1440 x 1080 pixels. Pediatric wide-field fundus photograph:
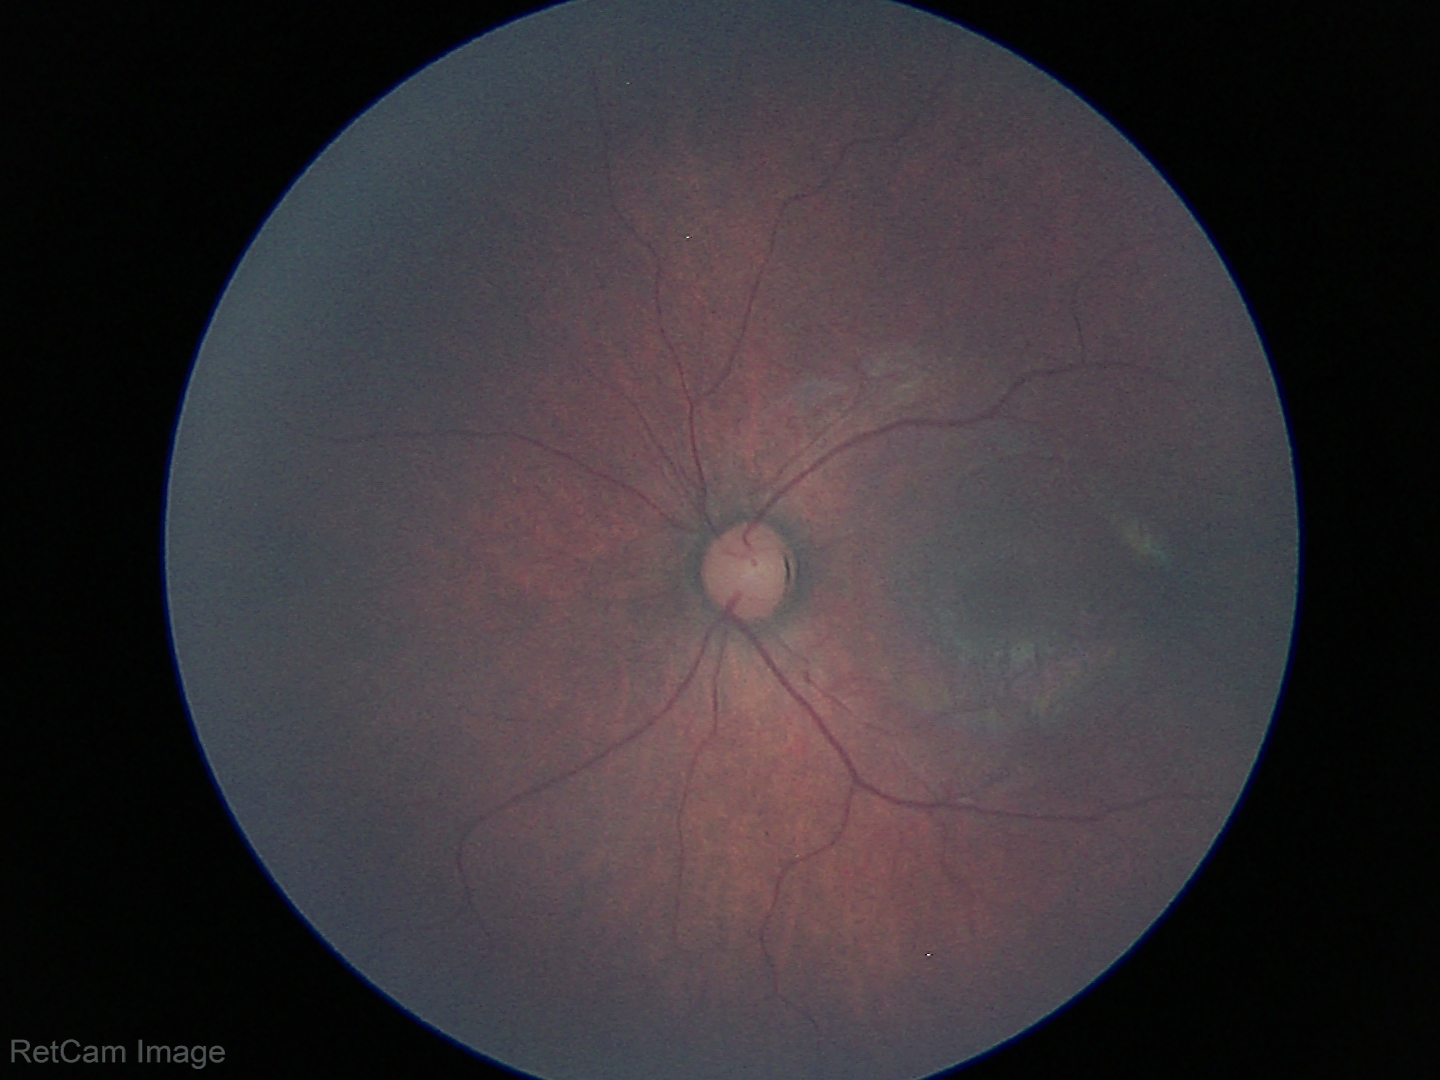 Screening examination diagnosed as physiological.